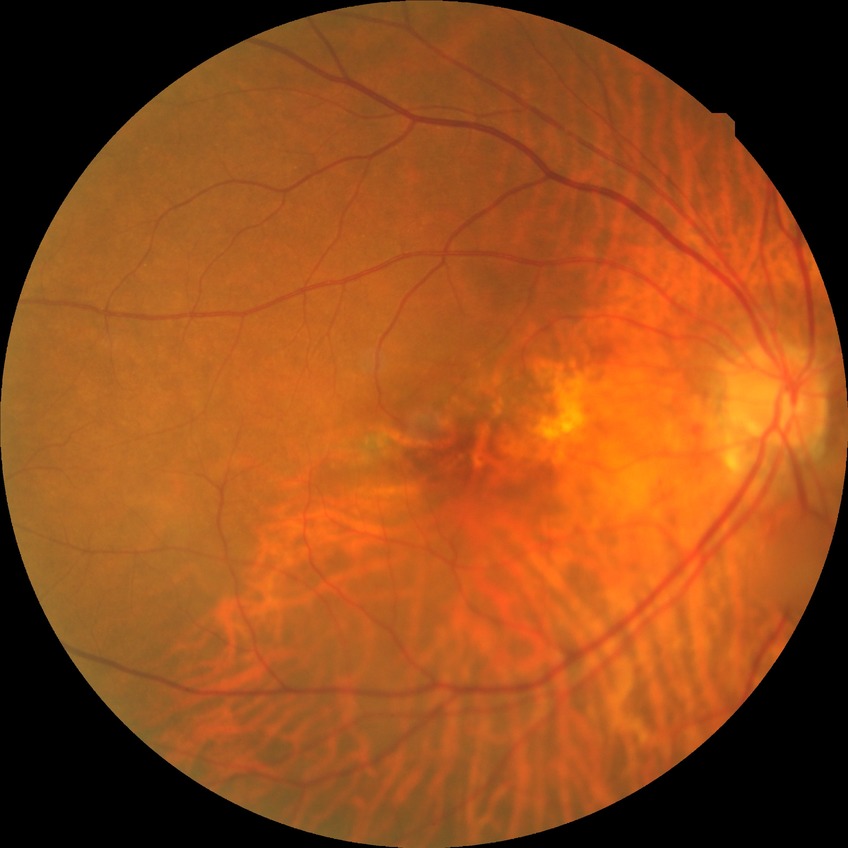

DR stage is SDR.